45° FOV · nonmydriatic · NIDEK AFC-230 · modified Davis classification · posterior pole photograph:
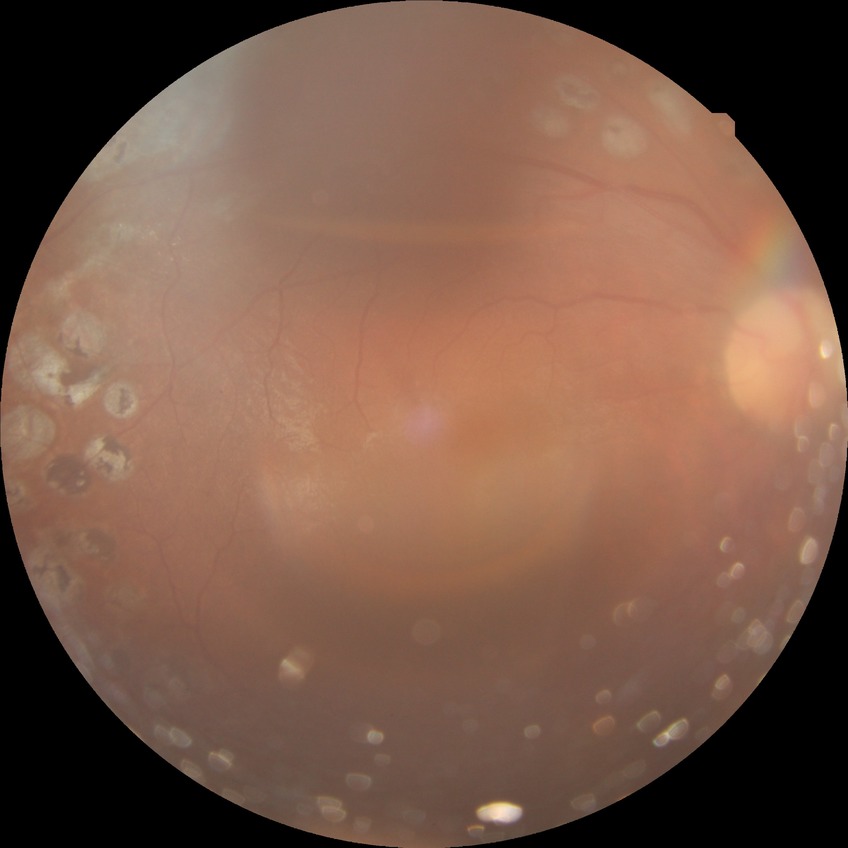 {"davis_grade": "PDR"}